Wide-field contact fundus photograph of an infant.
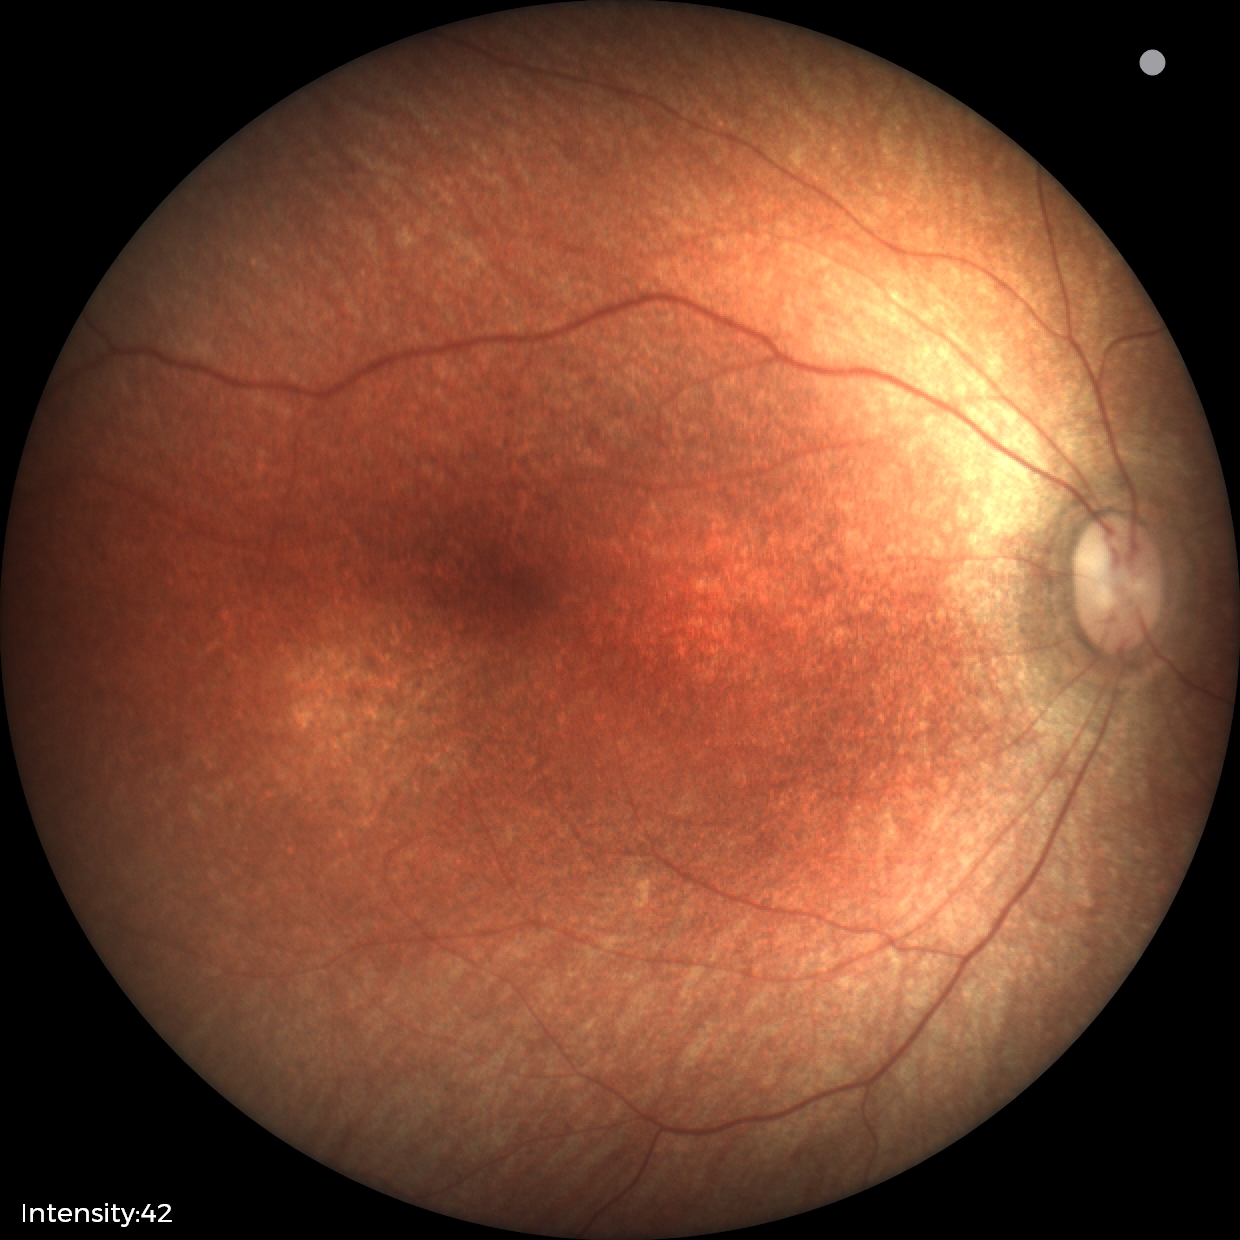
Normal screening examination.